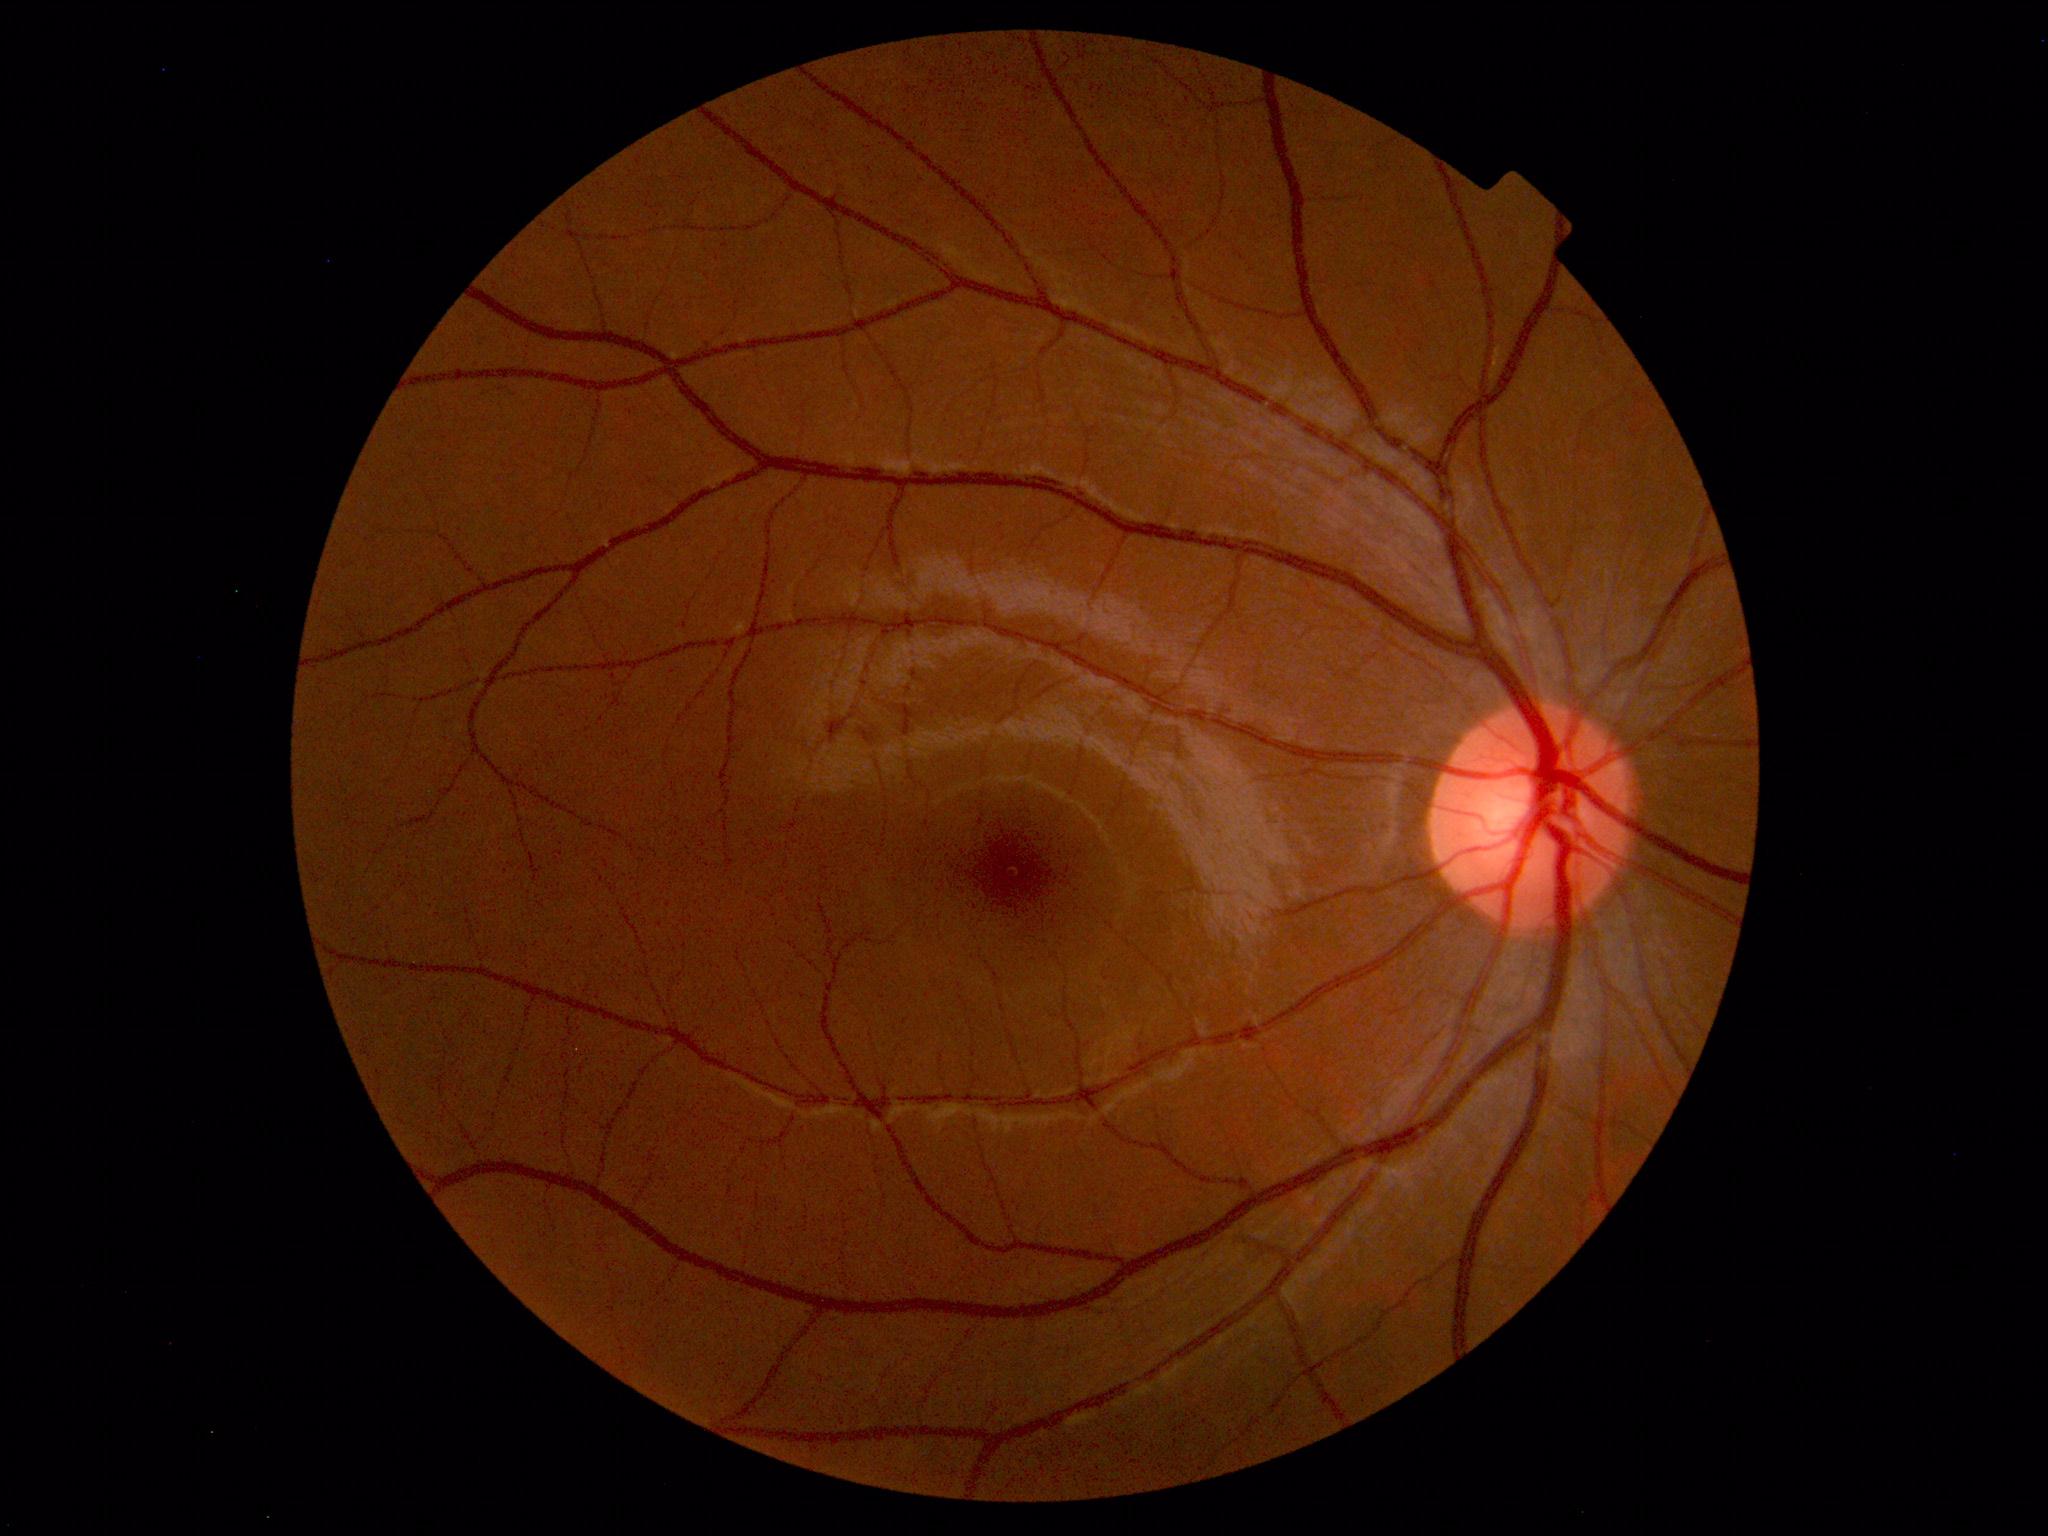
Impression: within normal limits.